2048x1536.
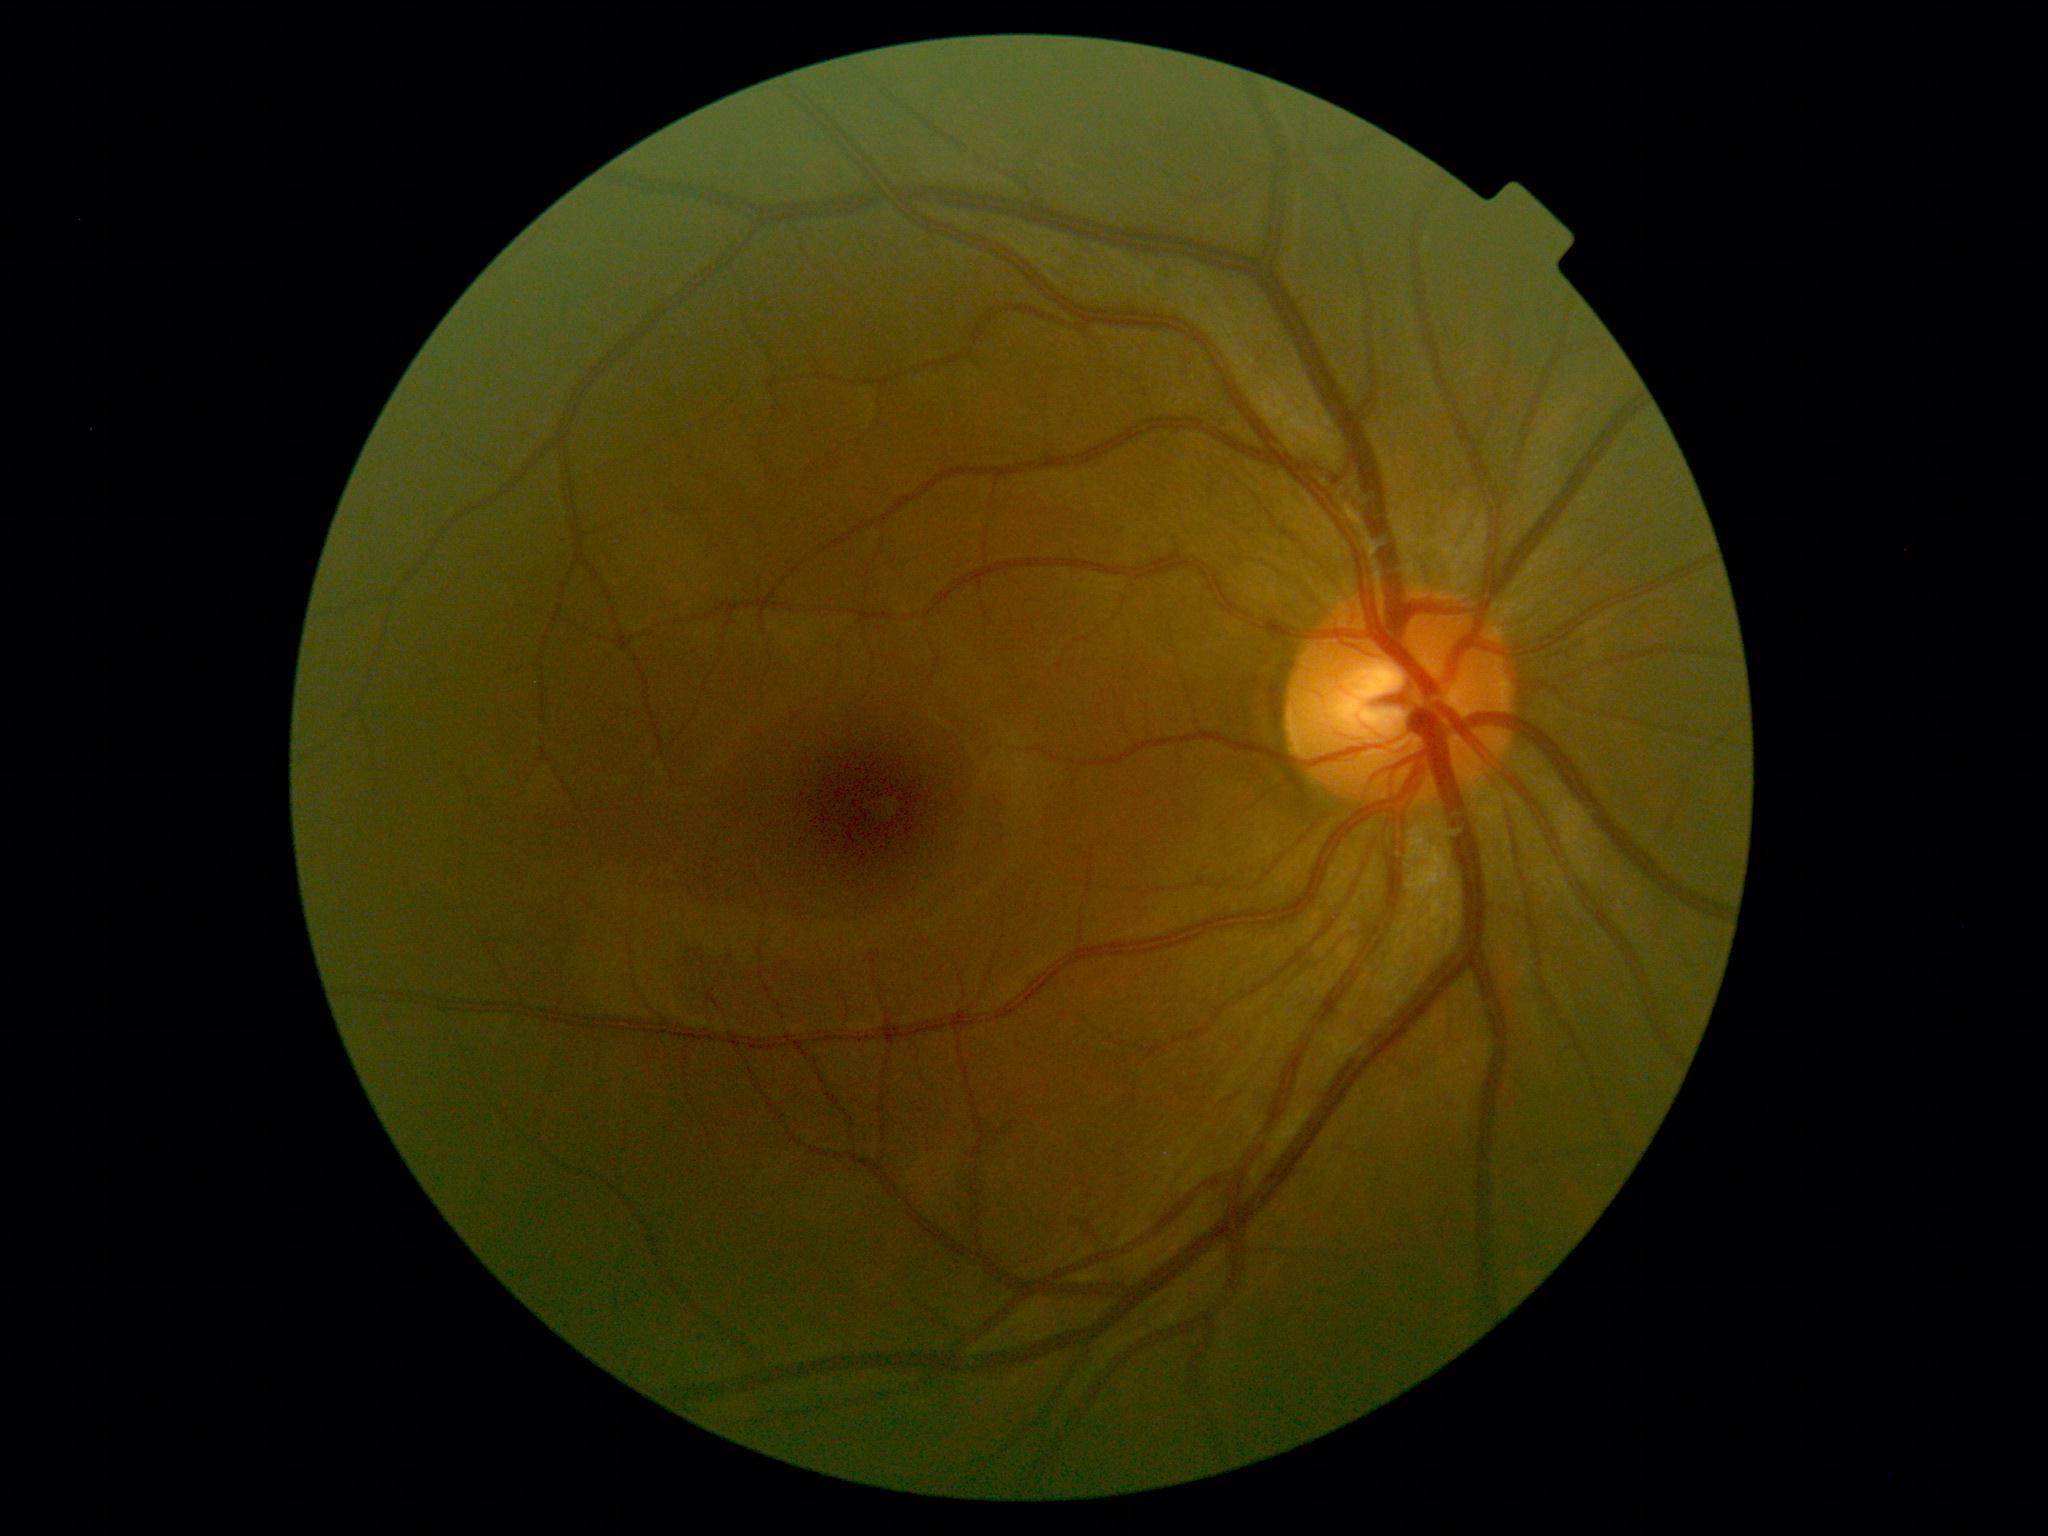 No apparent diabetic retinopathy.
DR stage: 0/4.